Captured with the Phoenix ICON (100° field of view). Pediatric retinal photograph (wide-field). 1240x1240 — 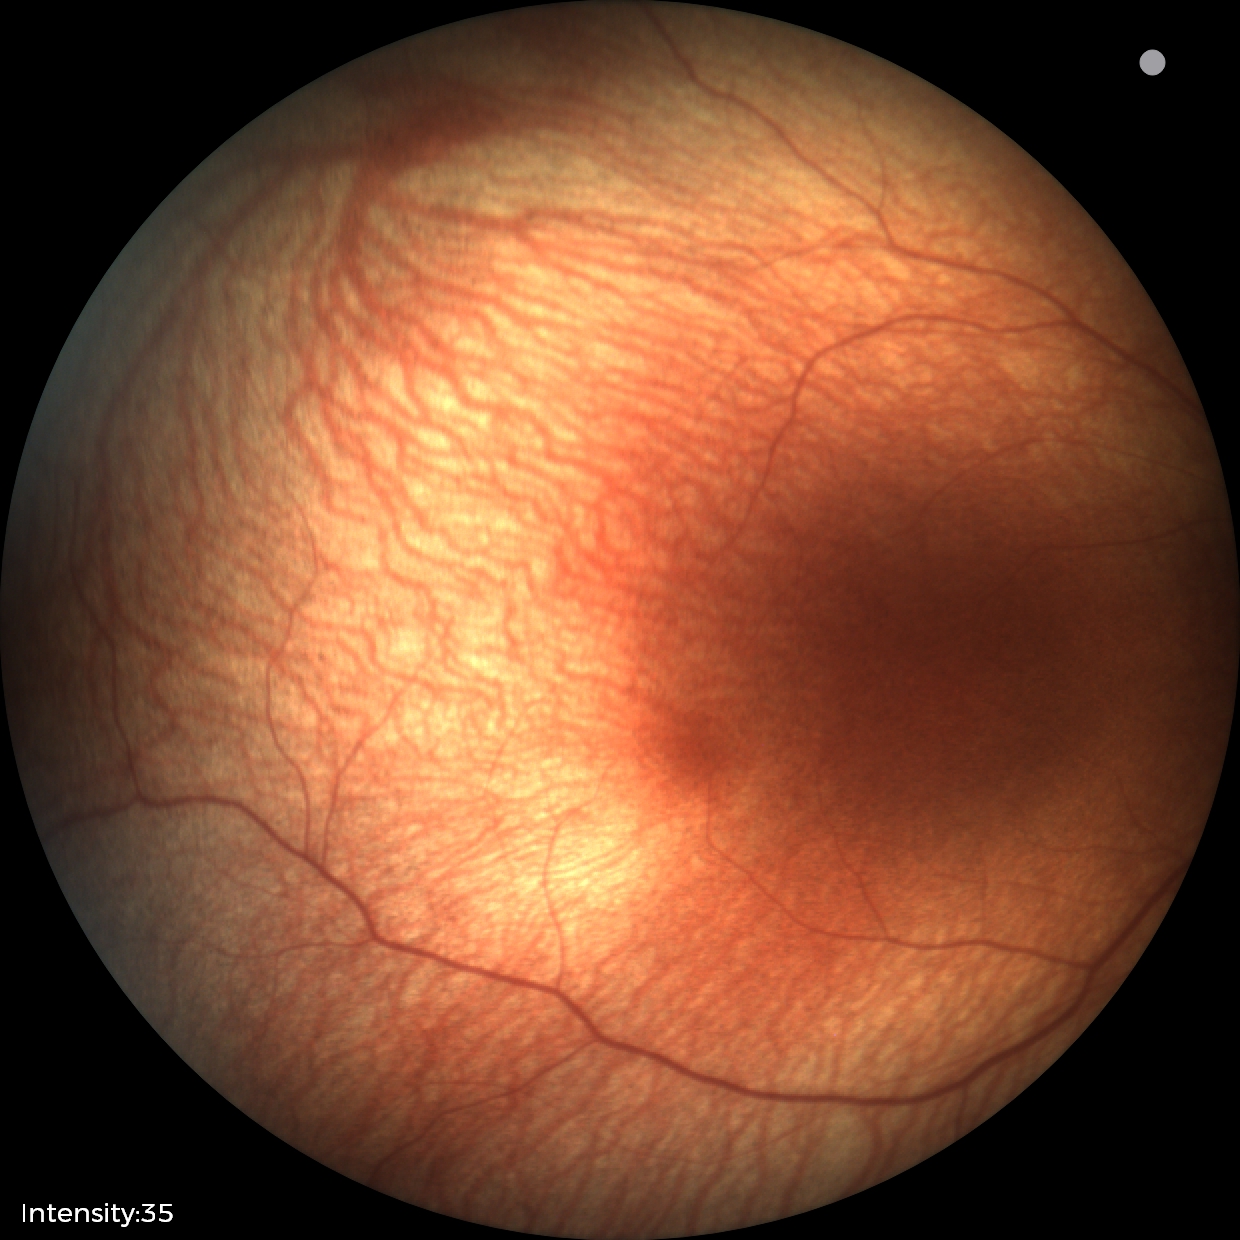 Screening examination with no abnormal retinal findings.